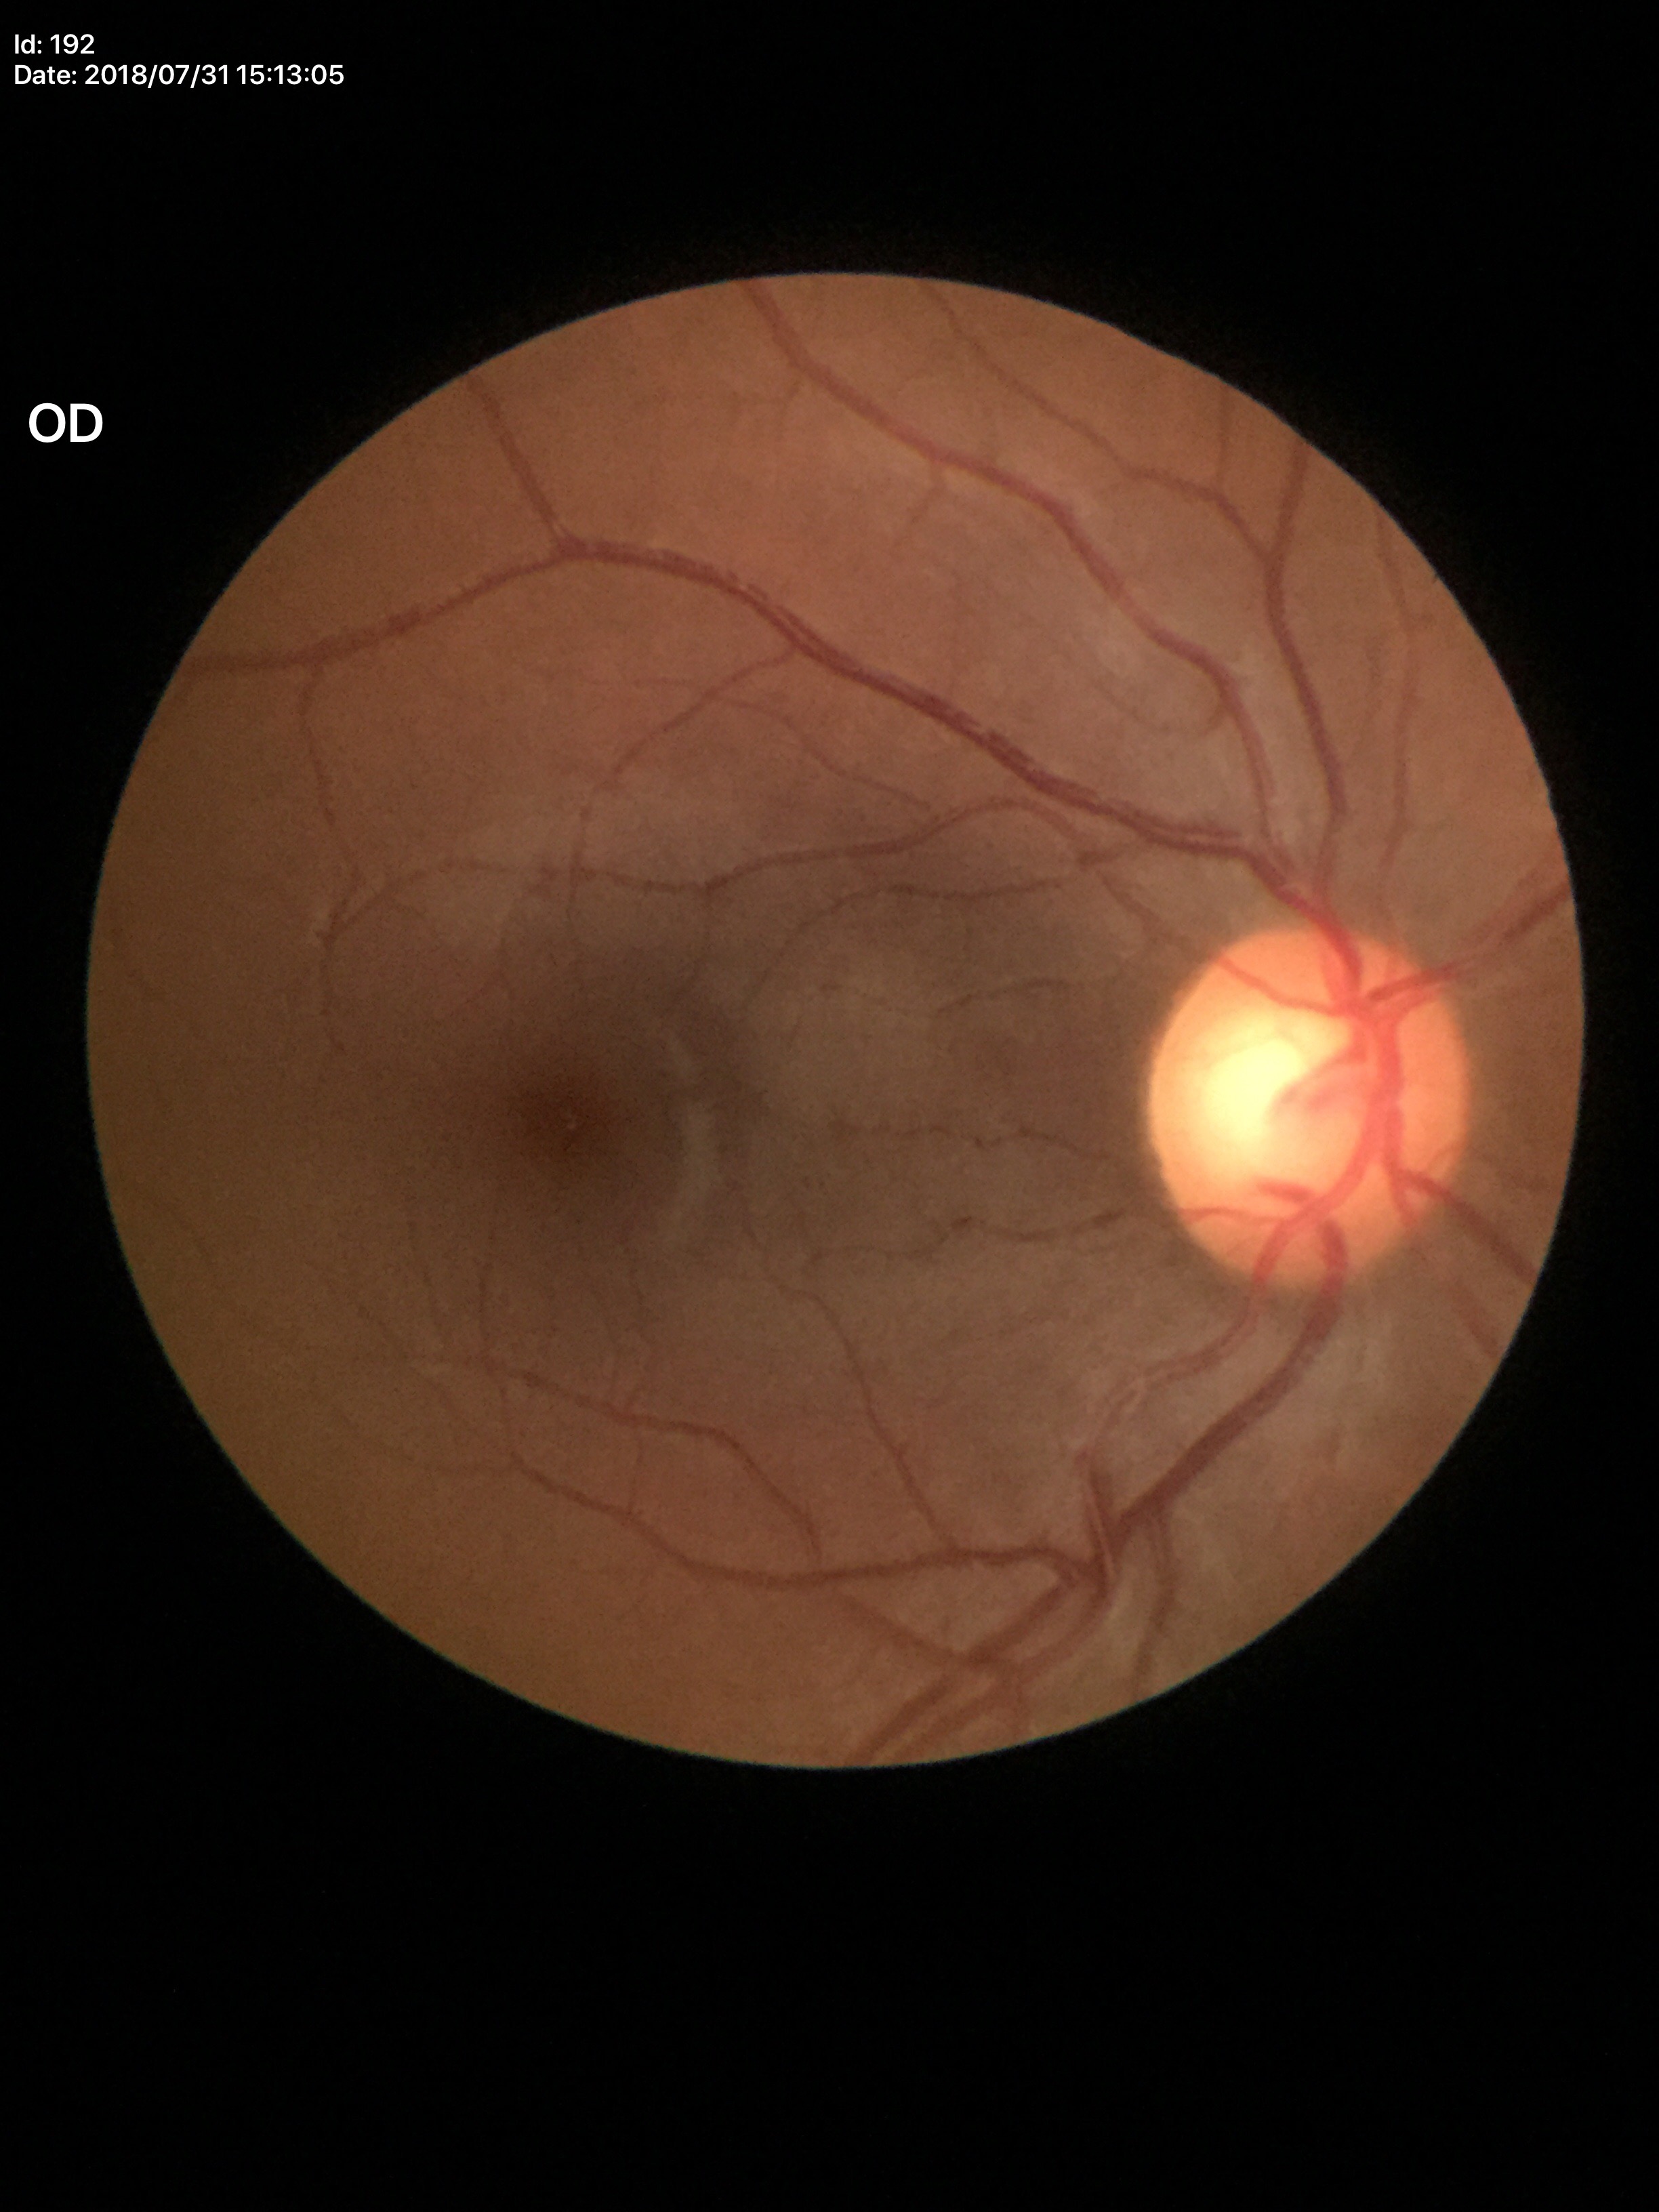

VCDR is 0.66.
Suspicious for glaucoma.
HCDR is 0.72.